Wide-field contact fundus photograph of an infant:
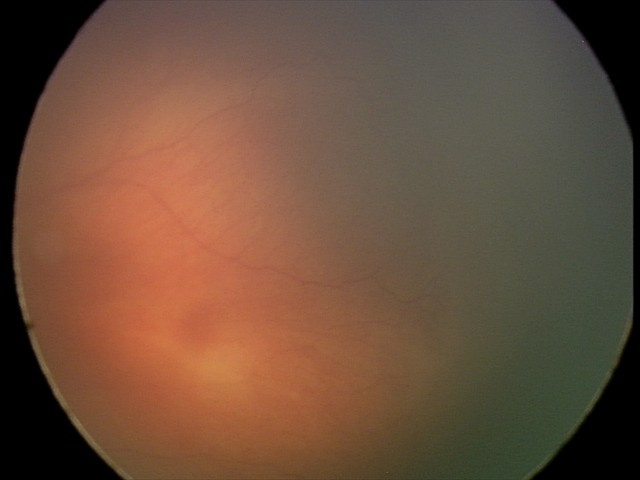 Examination diagnosed as retinopathy of prematurity stage 1.